45° FOV; CFP — 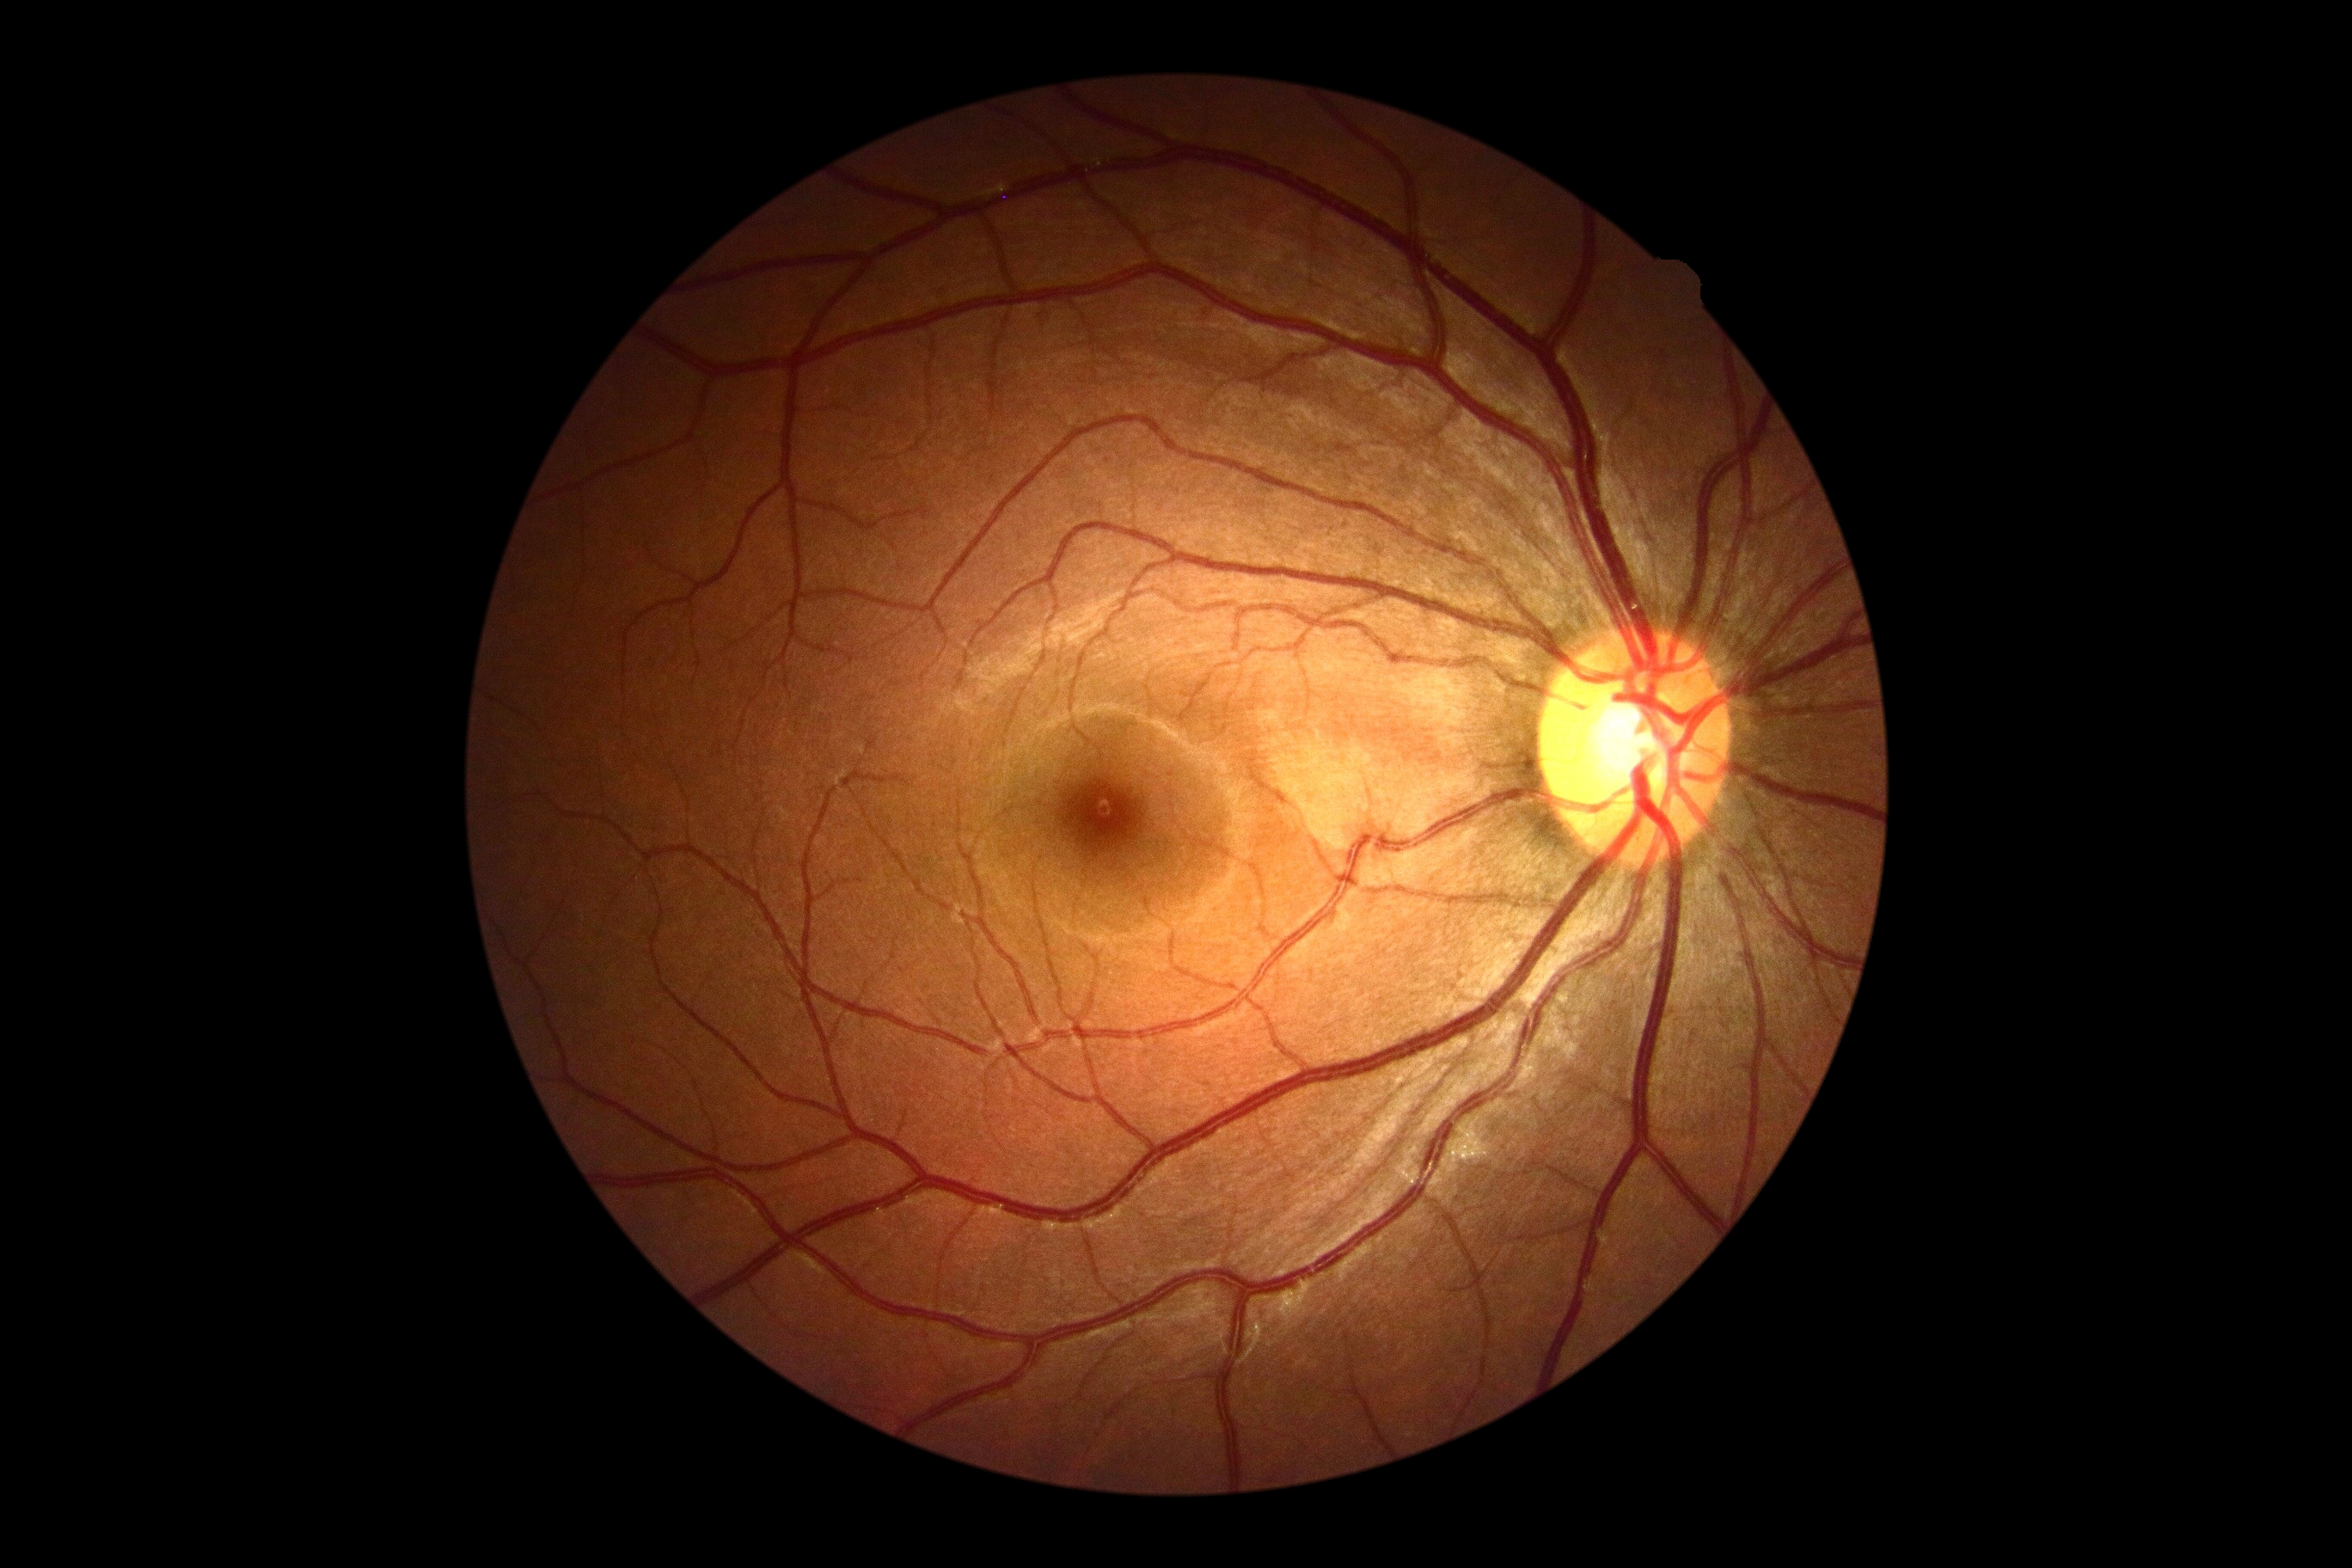 Diabetic retinopathy severity is grade 0 (no apparent retinopathy).